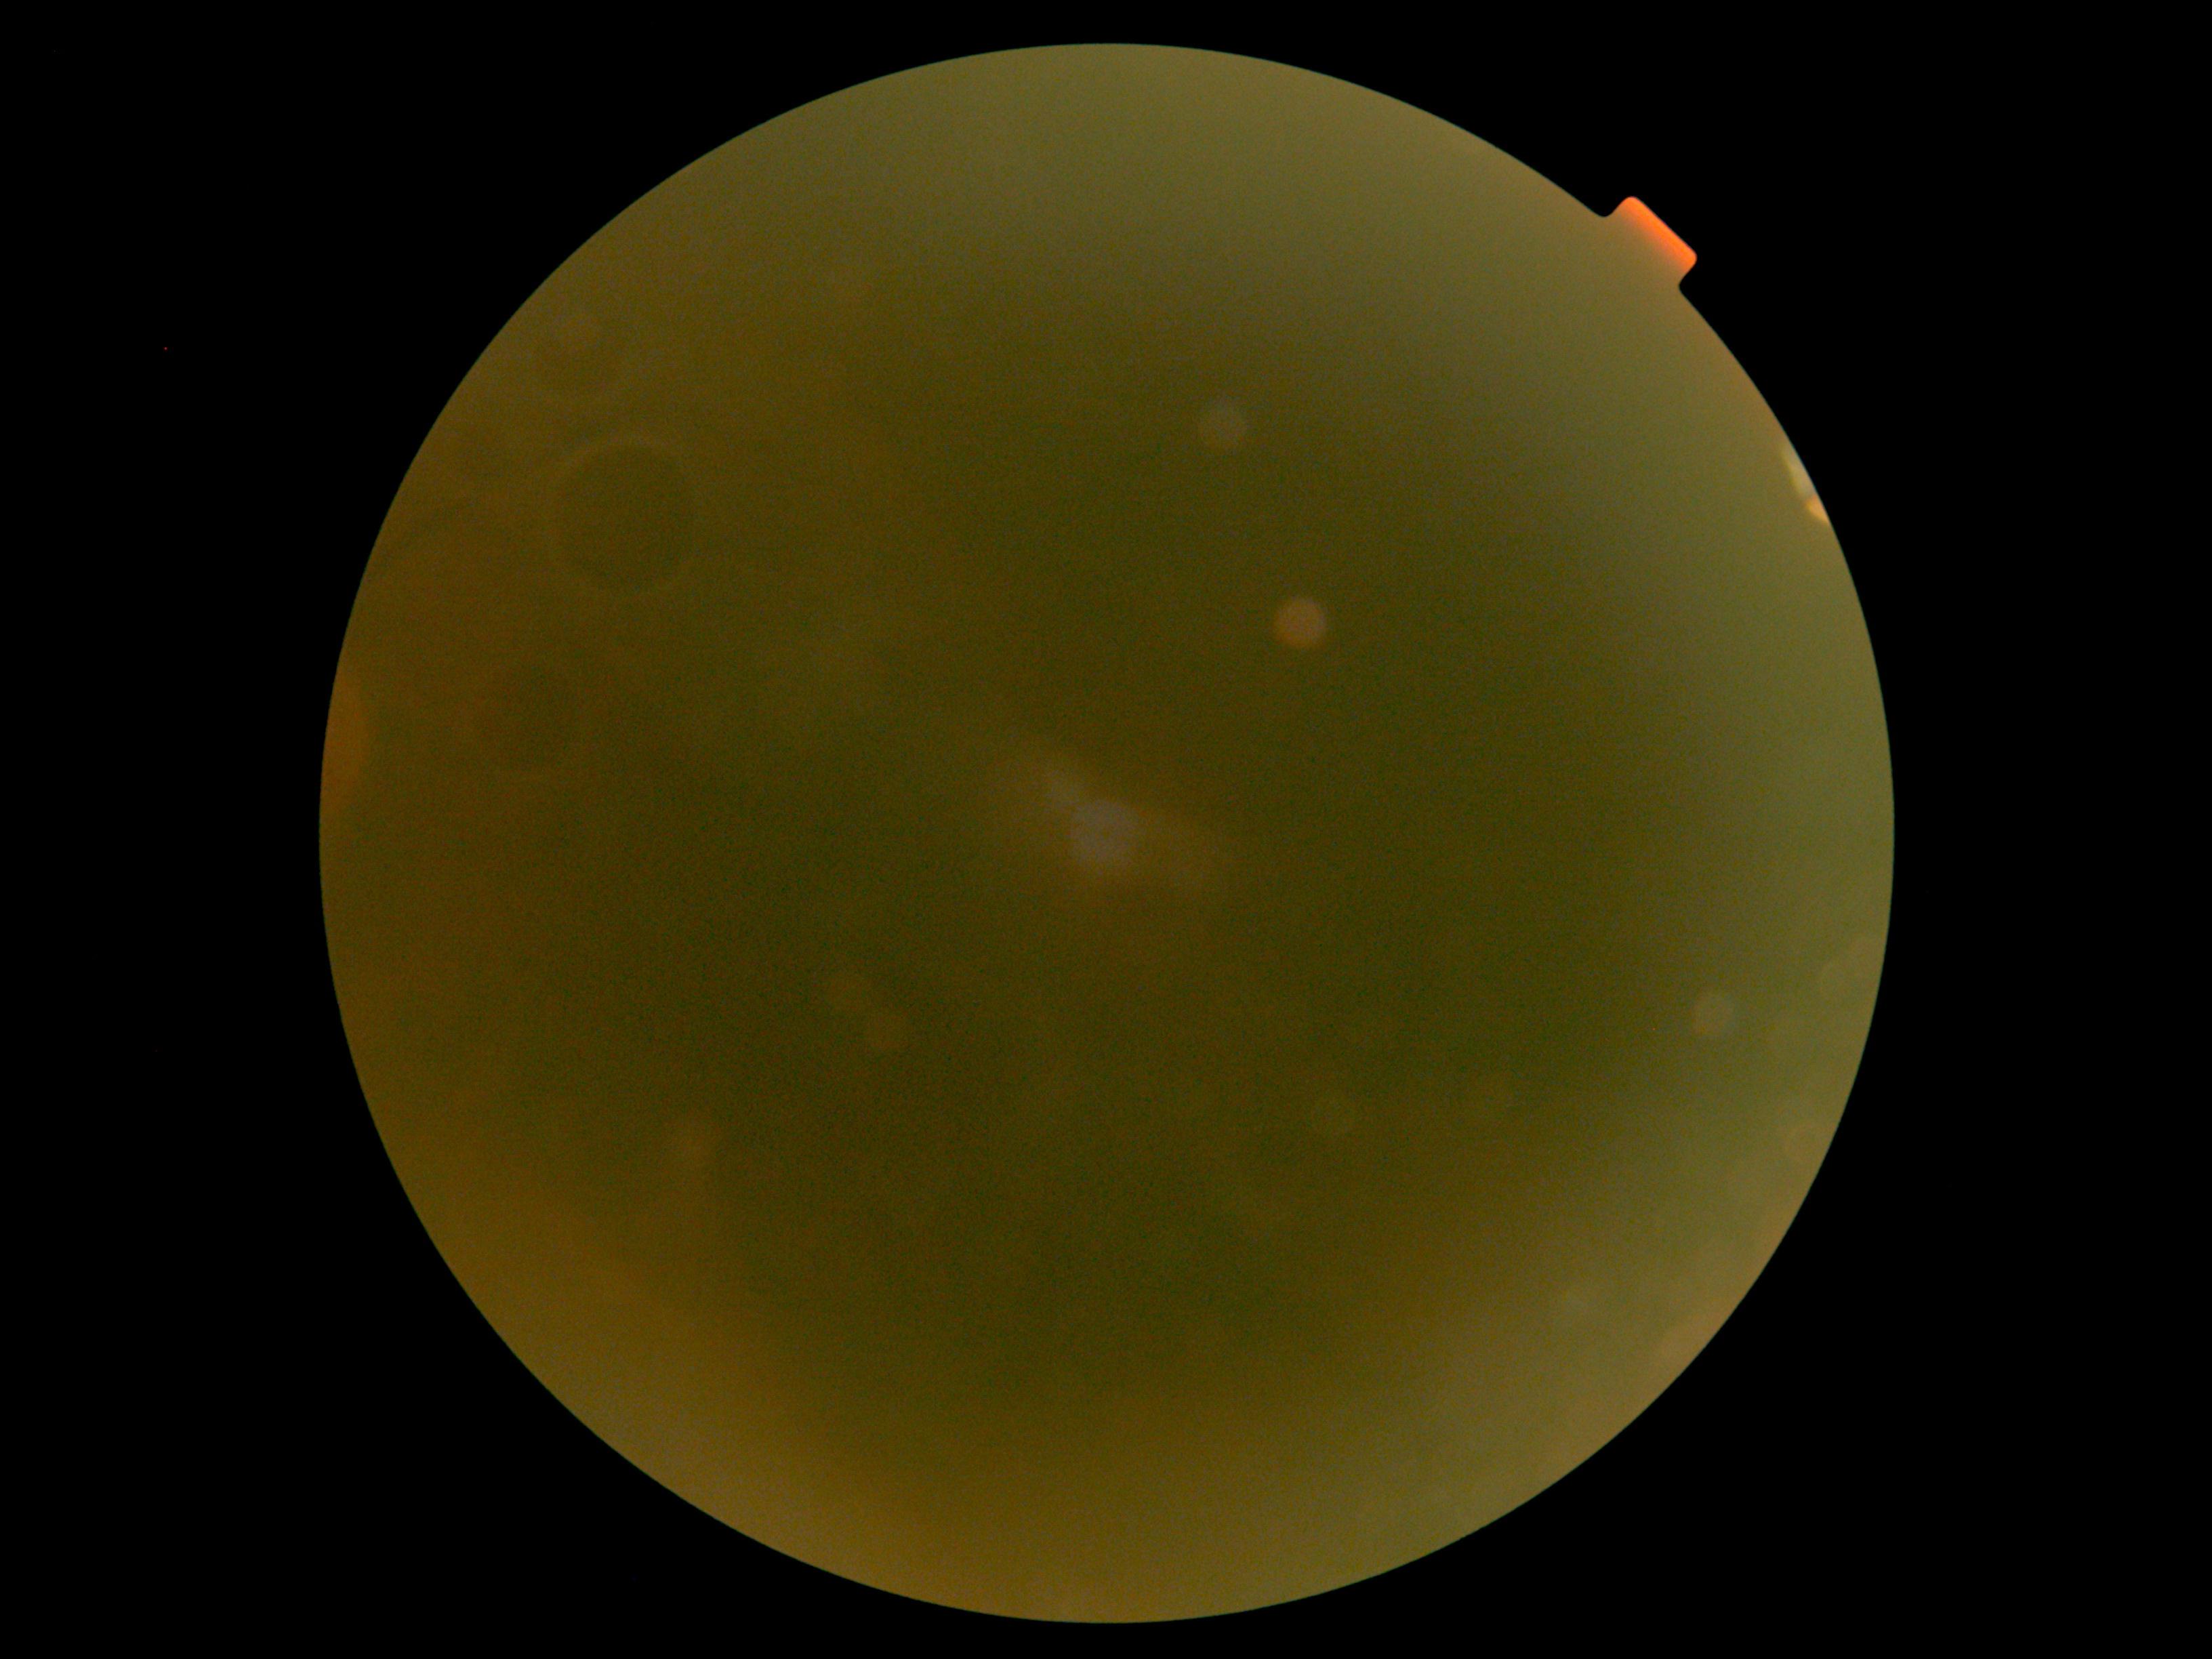 • DR grade: ungradable due to poor image quality